45° field of view · camera: NIDEK AFC-230 · Davis DR grading — 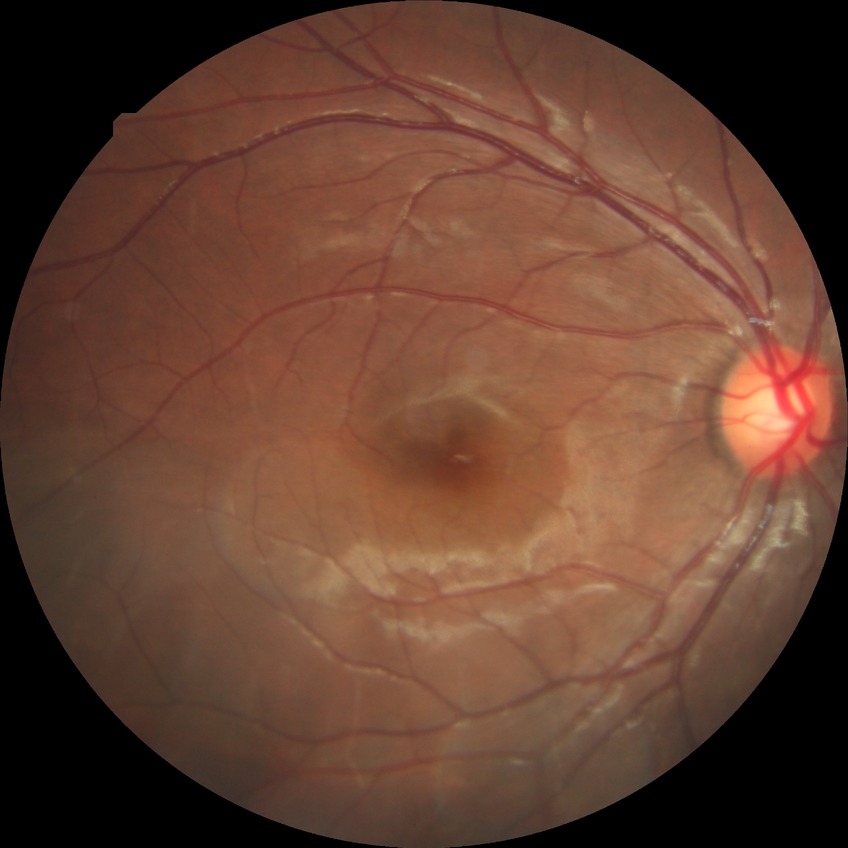
diabetic retinopathy severity: no diabetic retinopathy.